Camera: Clarity RetCam 3 (130° FOV); wide-field contact fundus photograph of an infant: 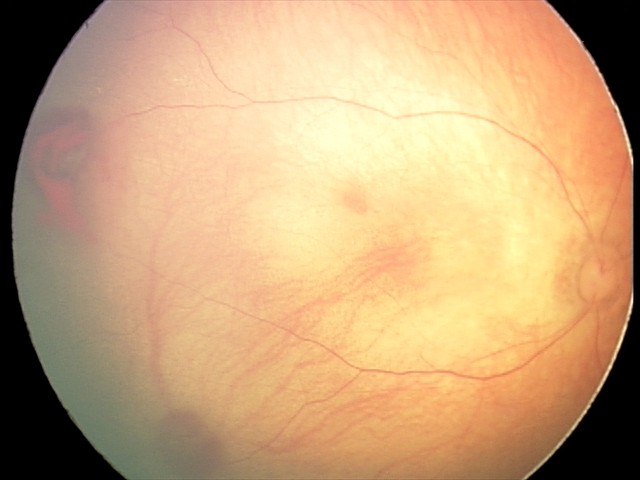
Impression: retinal hemorrhages.